Graded on the modified Davis scale
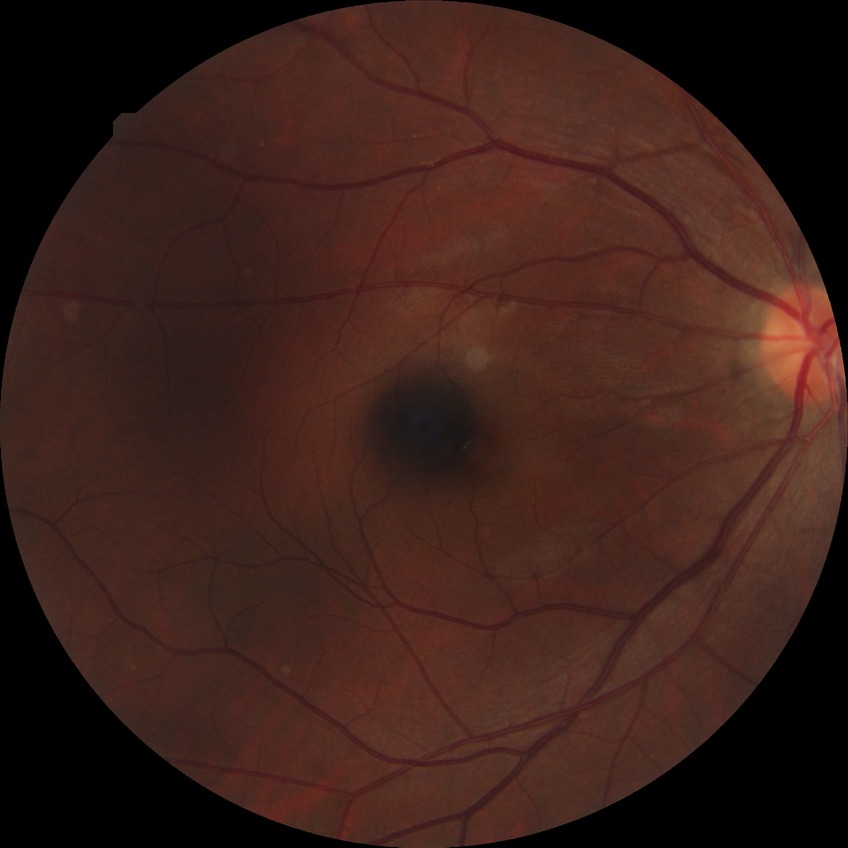
Diabetic retinopathy (DR) is no diabetic retinopathy (NDR).